848x848px. Camera: NIDEK AFC-230. Davis DR grading. Color fundus image: 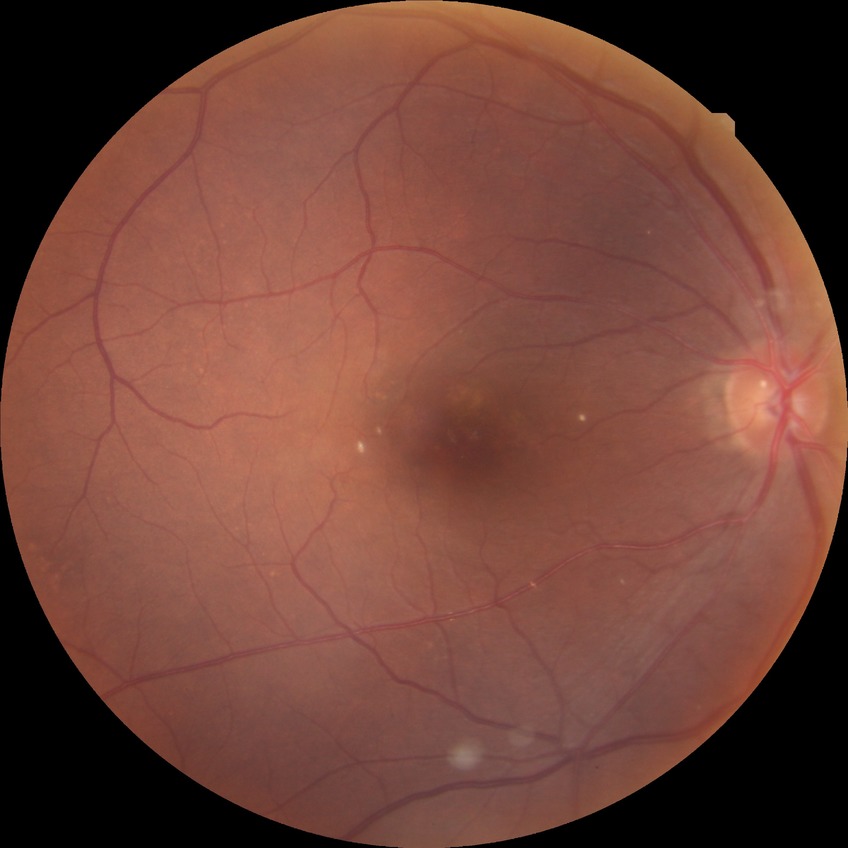

Retinopathy grade: no diabetic retinopathy.